35° FOV before cropping, fundus image cropped to the optic disc:
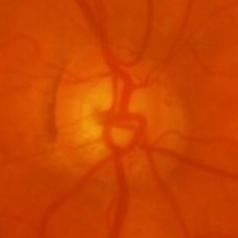
Glaucomatous changes are present. Optic disc appearance consistent with evidence of glaucoma.